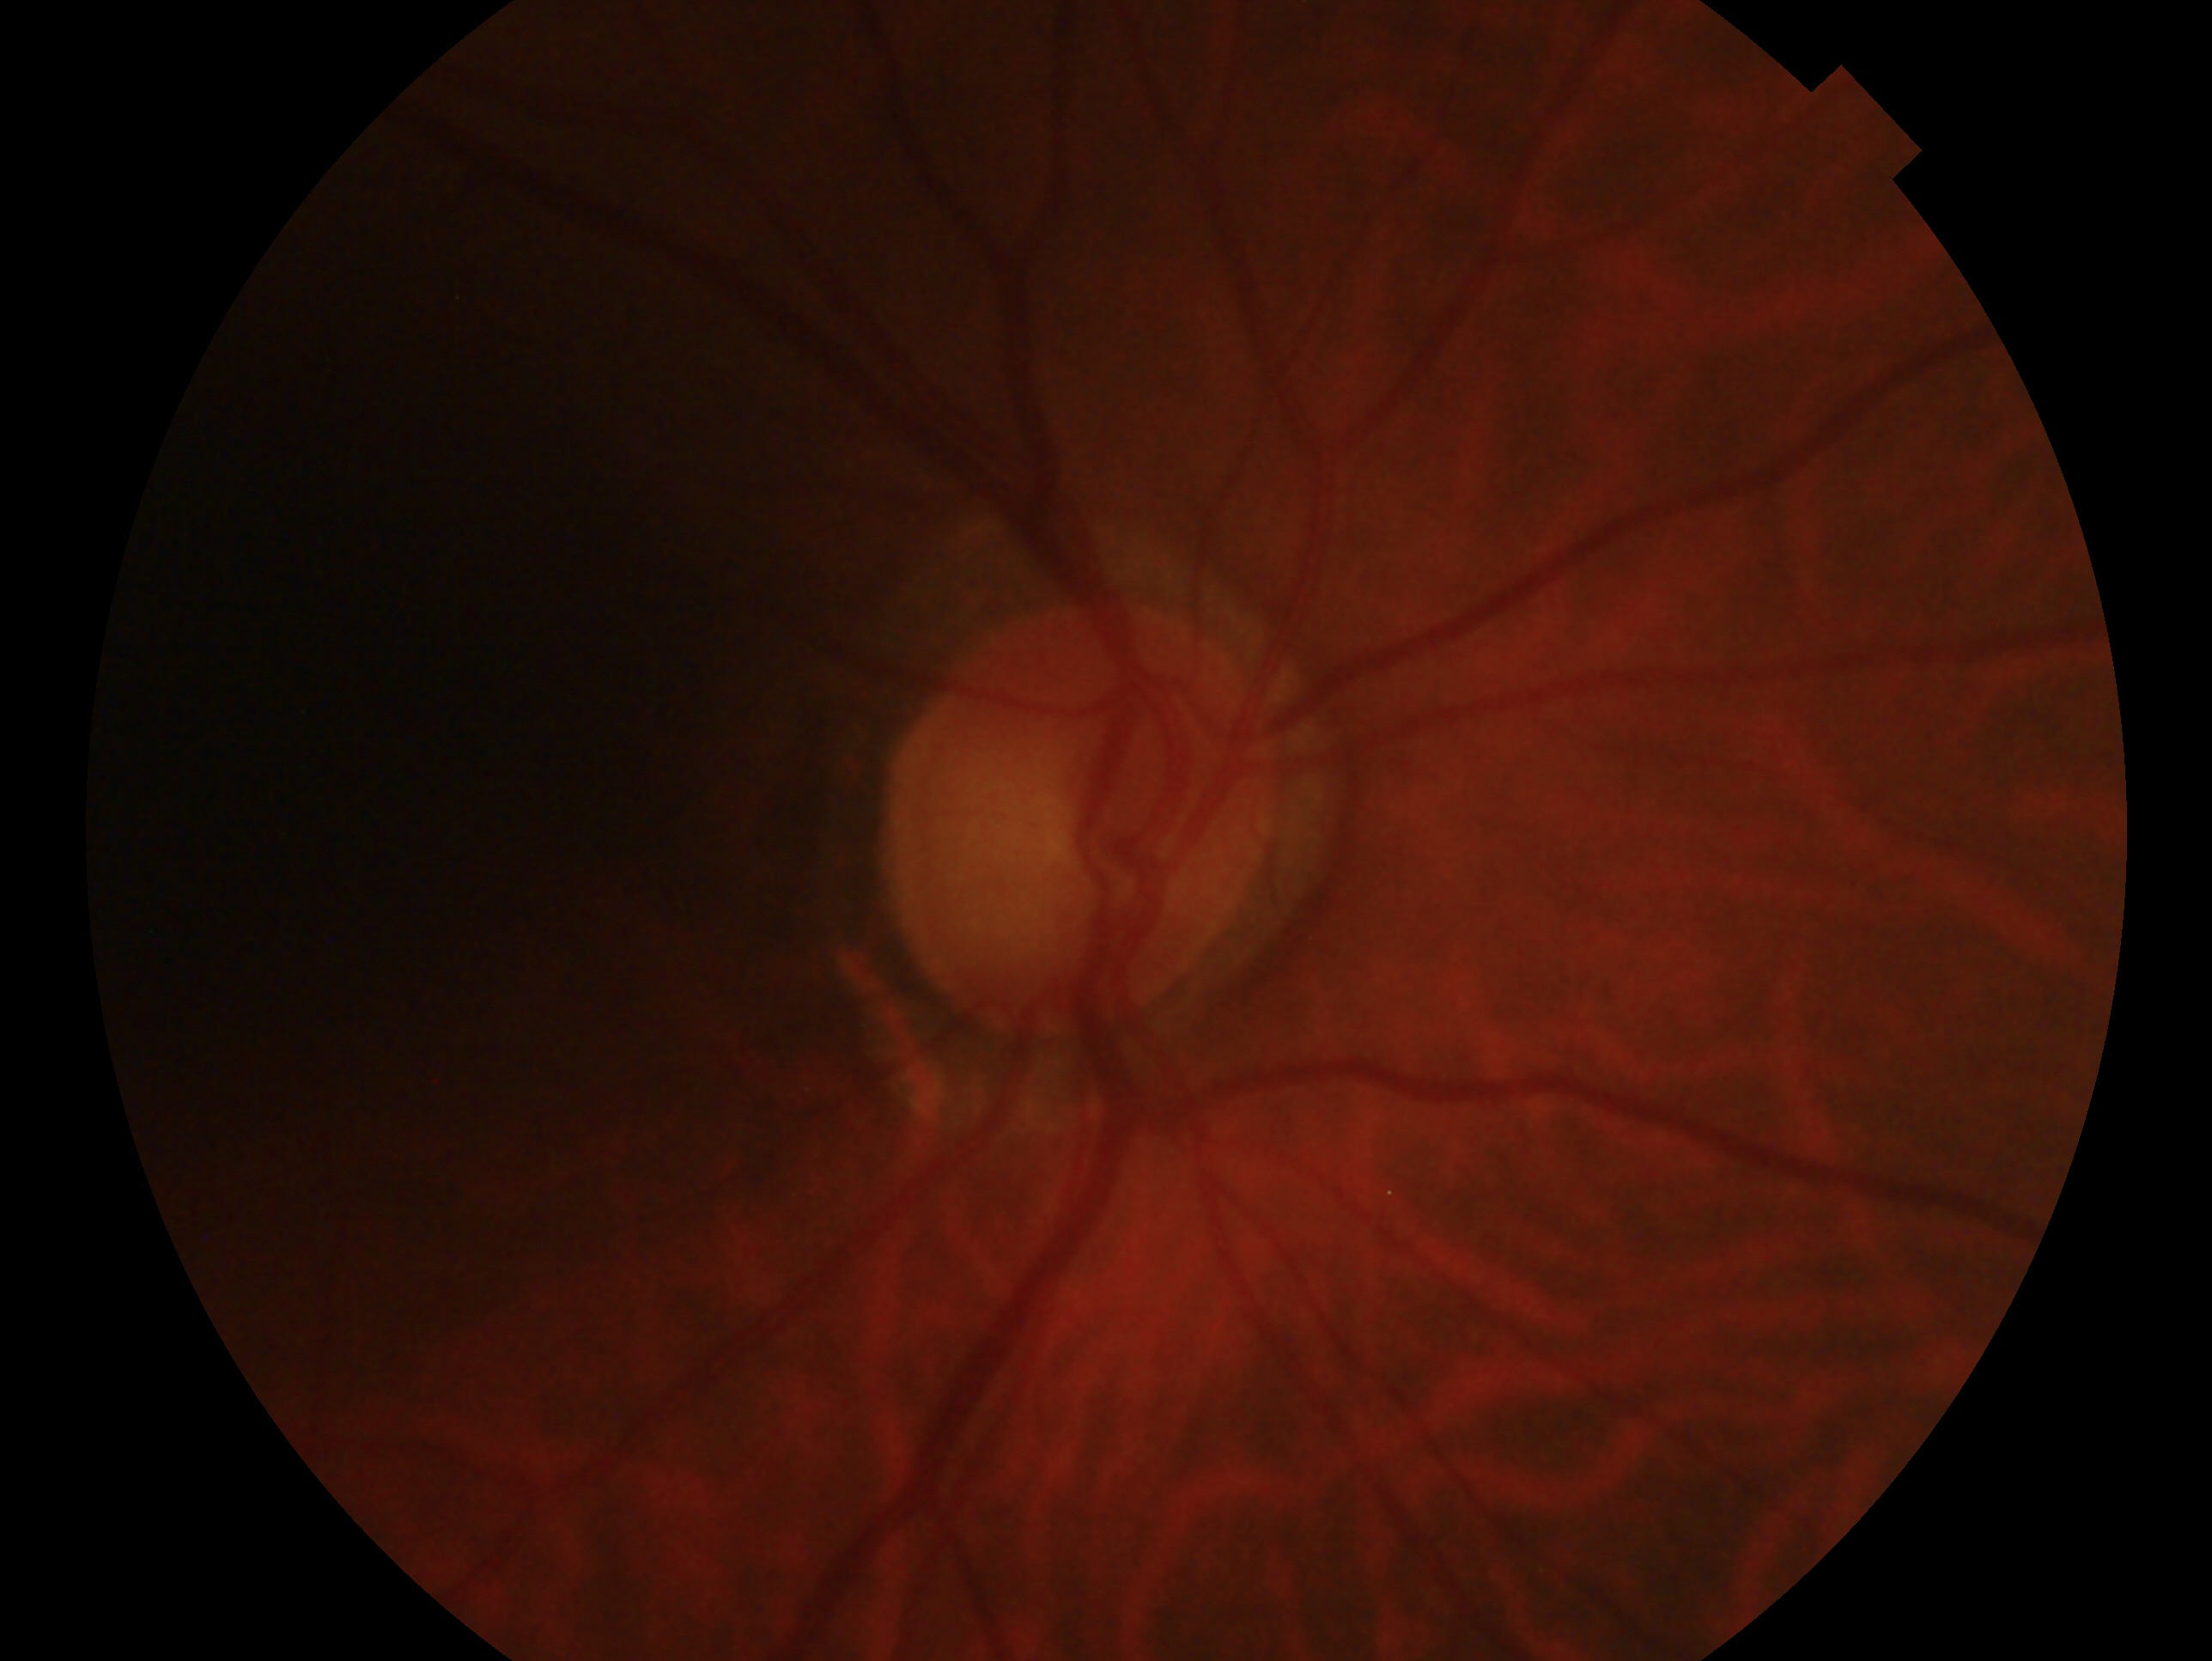

laterality = oculus dexter
glaucoma diagnosis = glaucomatous optic neuropathy